2352 by 1568 pixels, 45° field of view
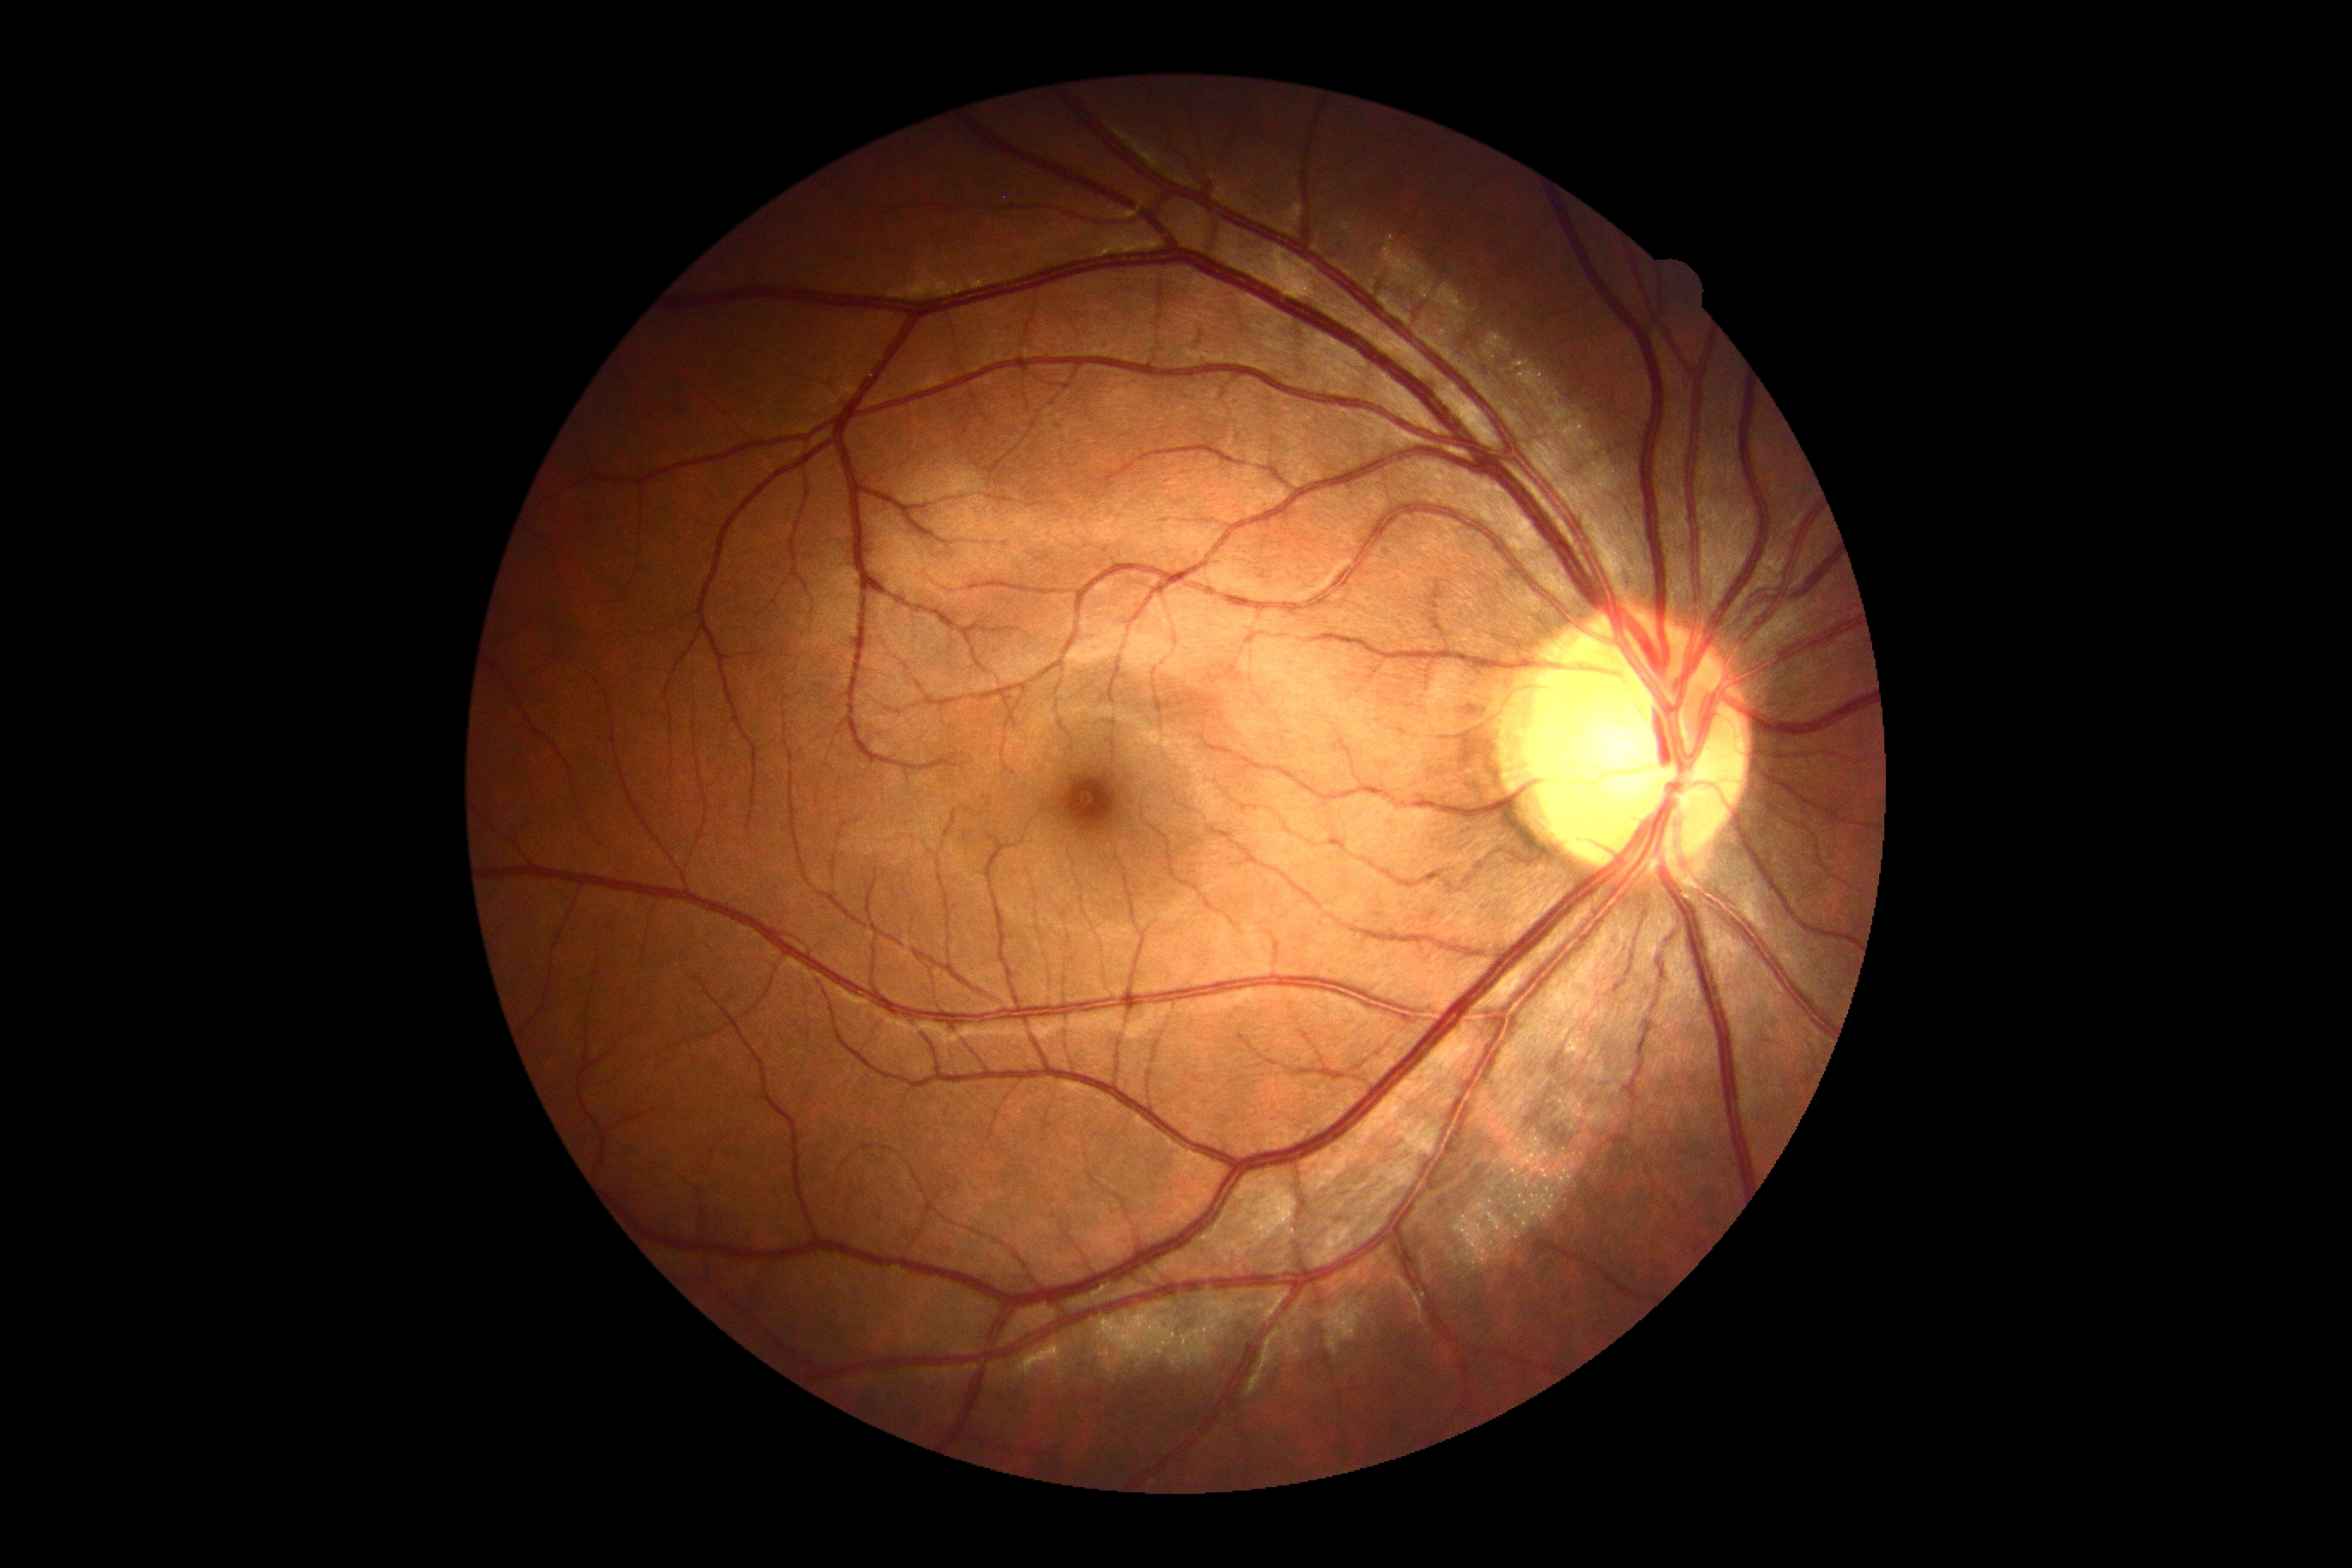
diabetic retinopathy severity = grade 0 (no apparent retinopathy) — no visible signs of diabetic retinopathy; DR impression = no DR findings.